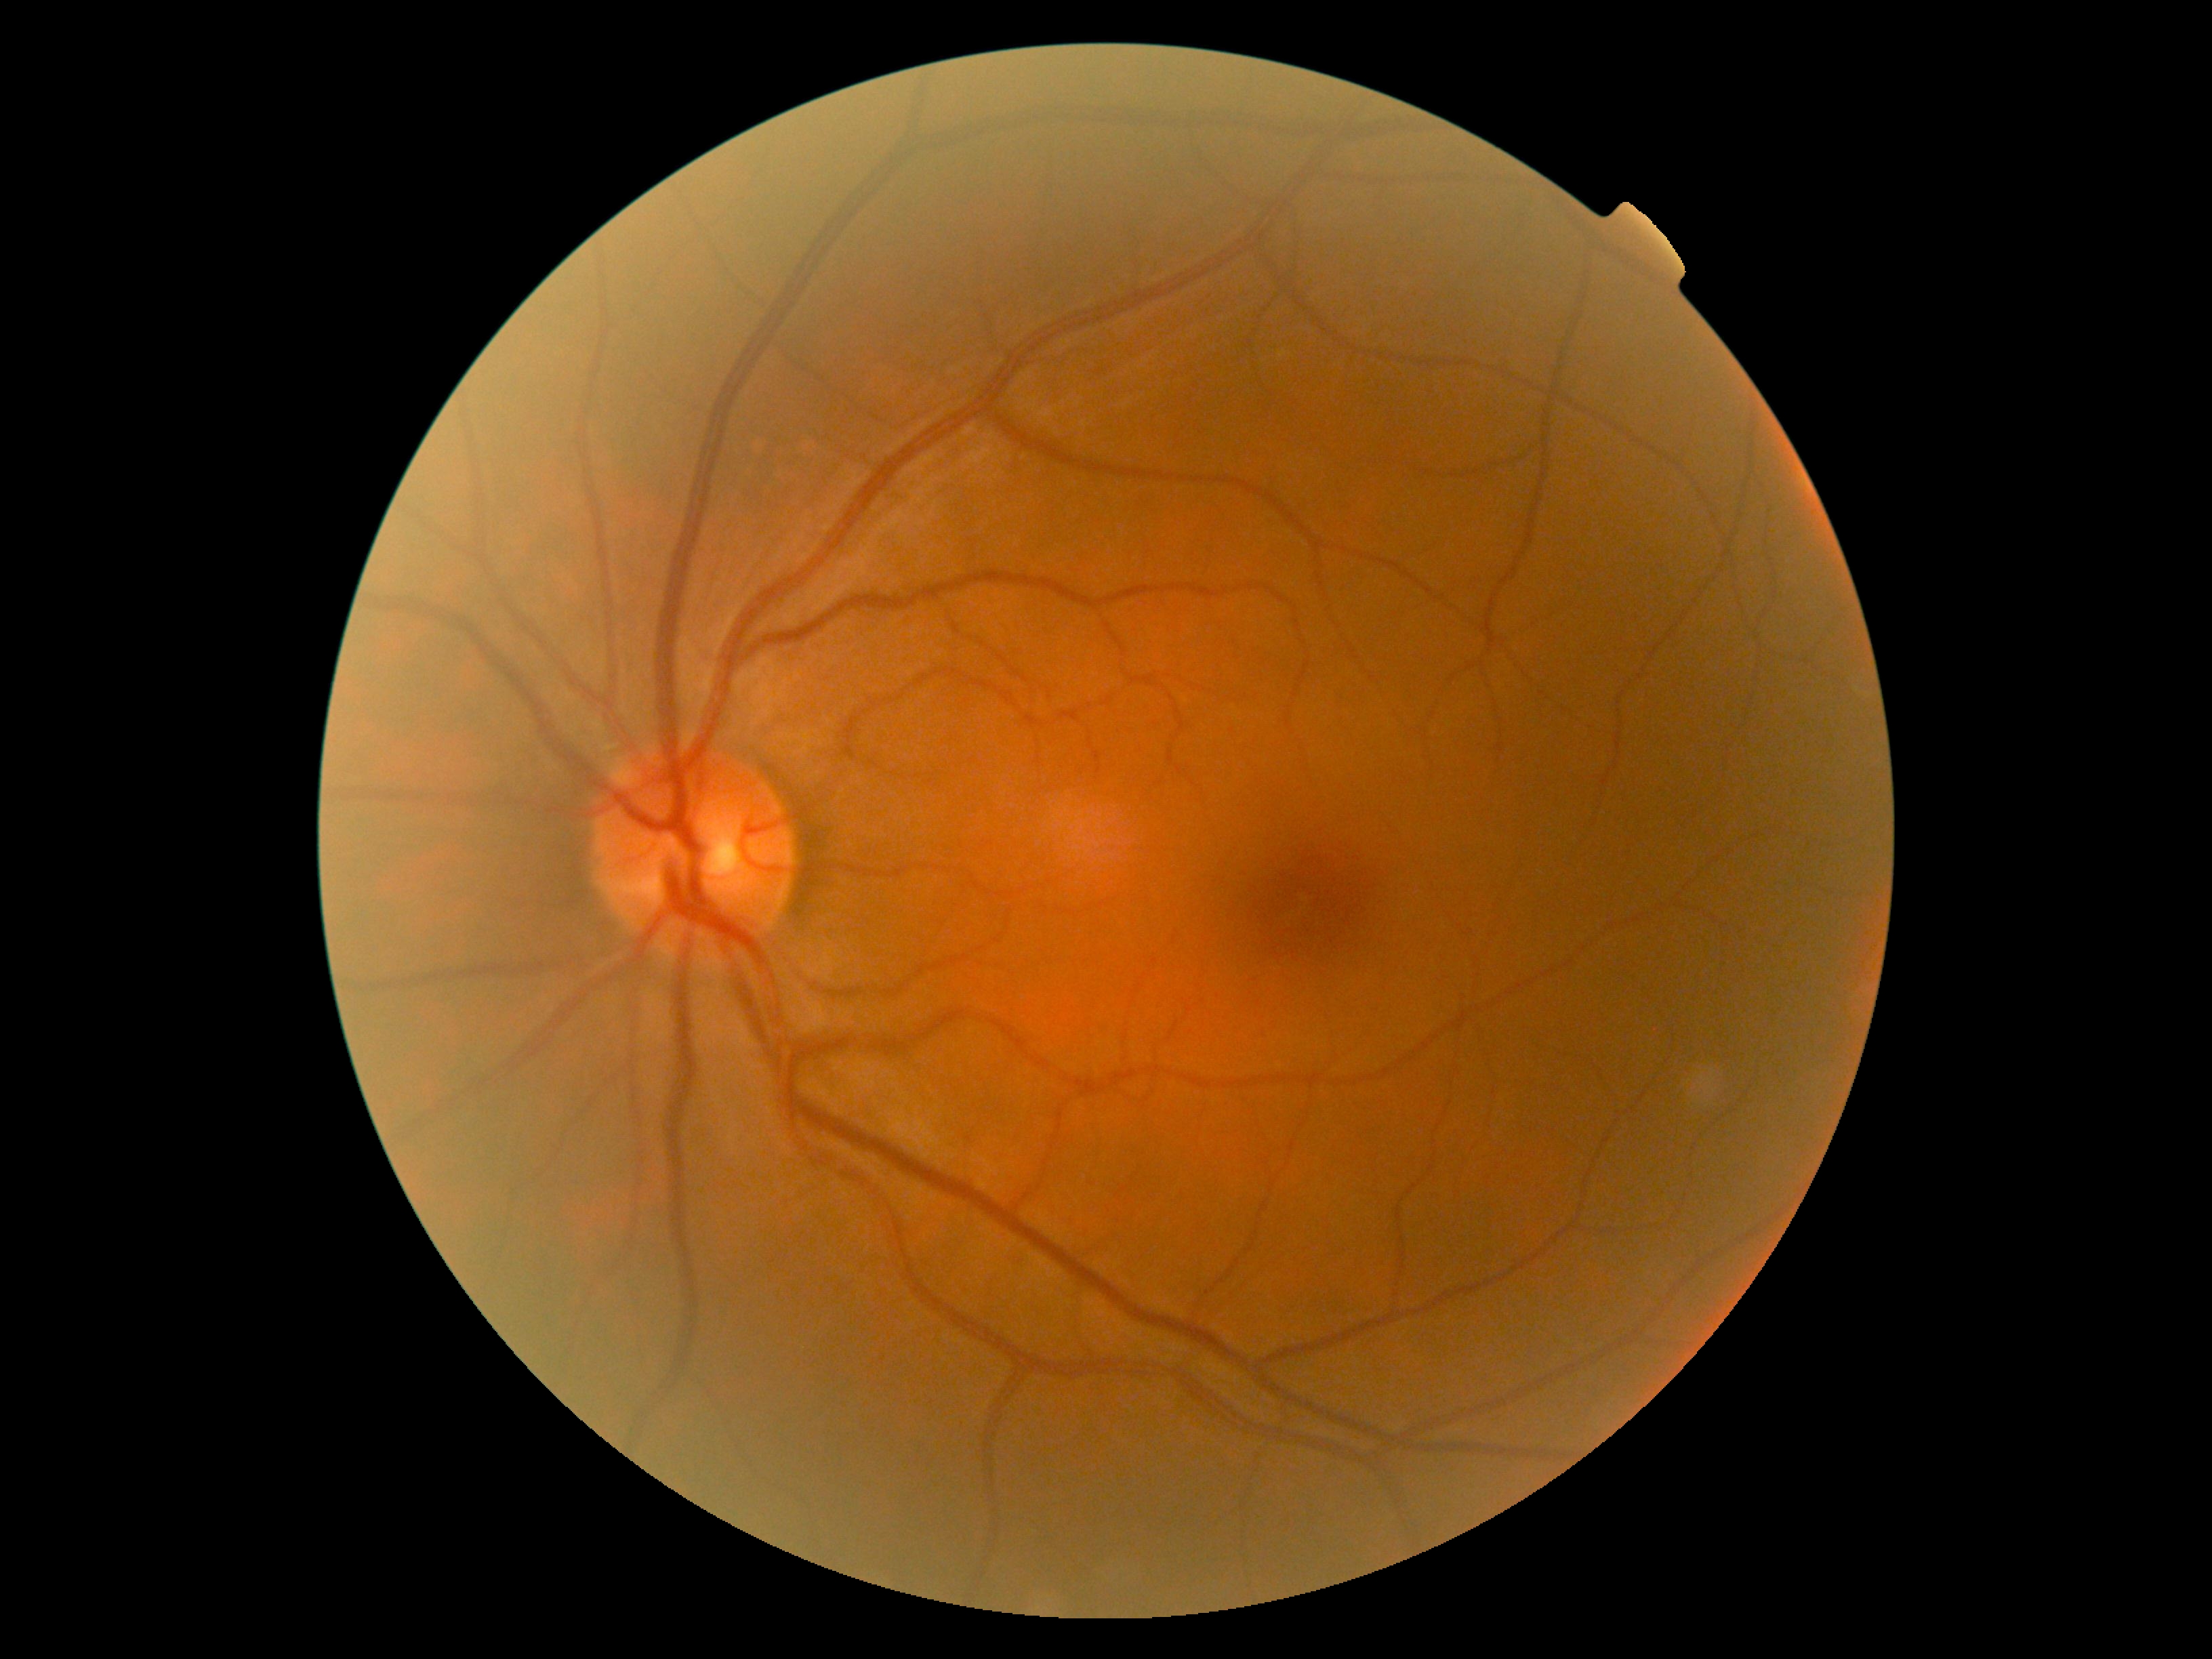
DR impression = no signs of DR | diabetic retinopathy severity = grade 0 (no apparent retinopathy) — no visible signs of diabetic retinopathy.